1440x1080 · captured with the Natus RetCam Envision (130° field of view) · infant wide-field retinal image.
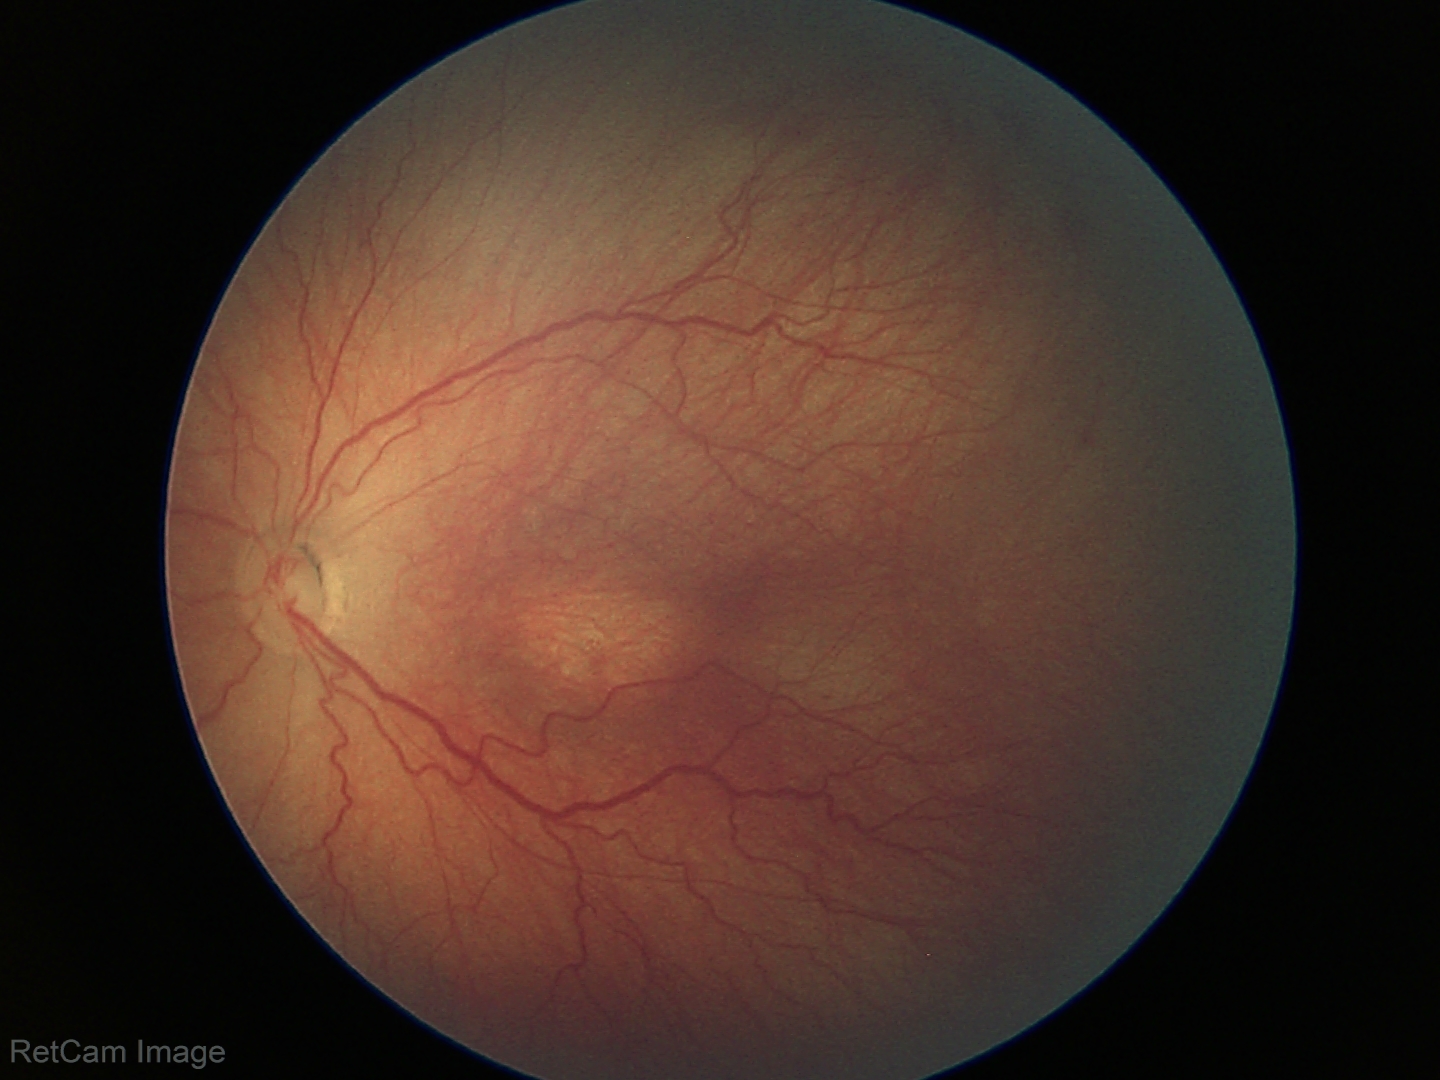 No plus disease. Series diagnosed as retinopathy of prematurity (ROP) stage 3.